50° field of view; CFP.
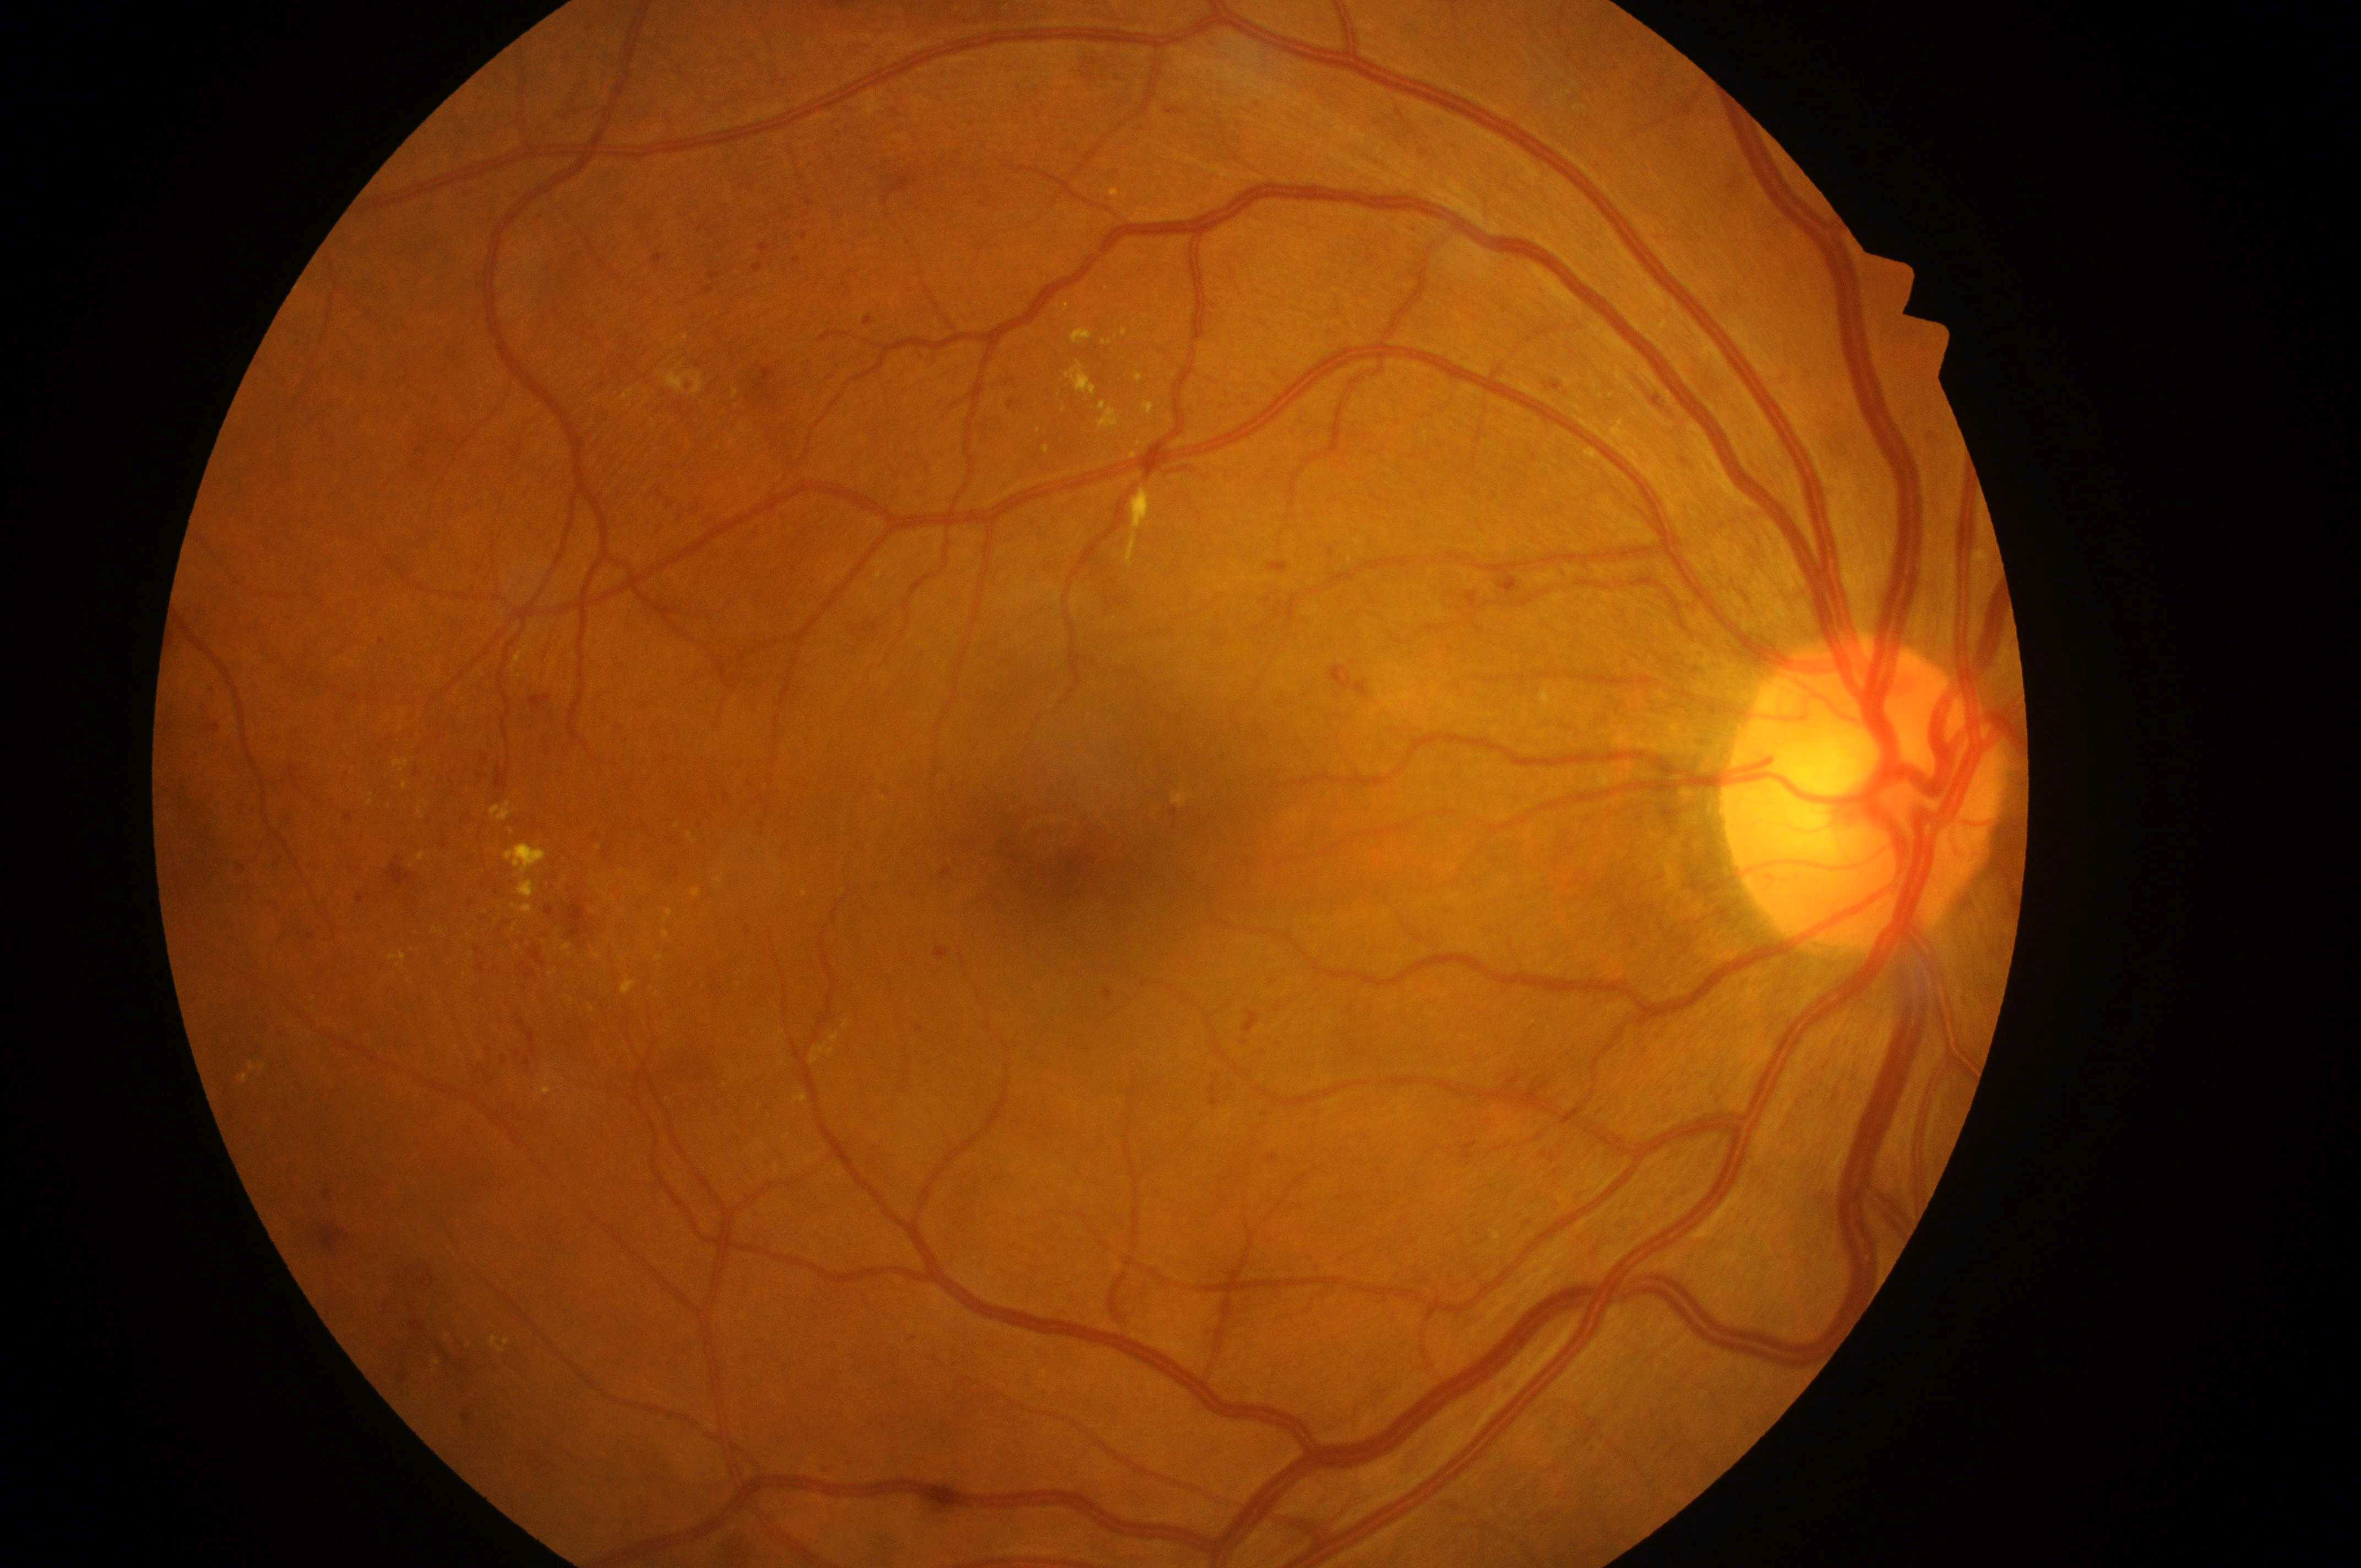
Diabetic macular edema (DME) is 2/2.
Disc center located at 1865px, 814px.
Diabetic retinopathy (DR): 3/4.
Fovea centralis located at 1067px, 864px.
Imaged eye: oculus dexter.